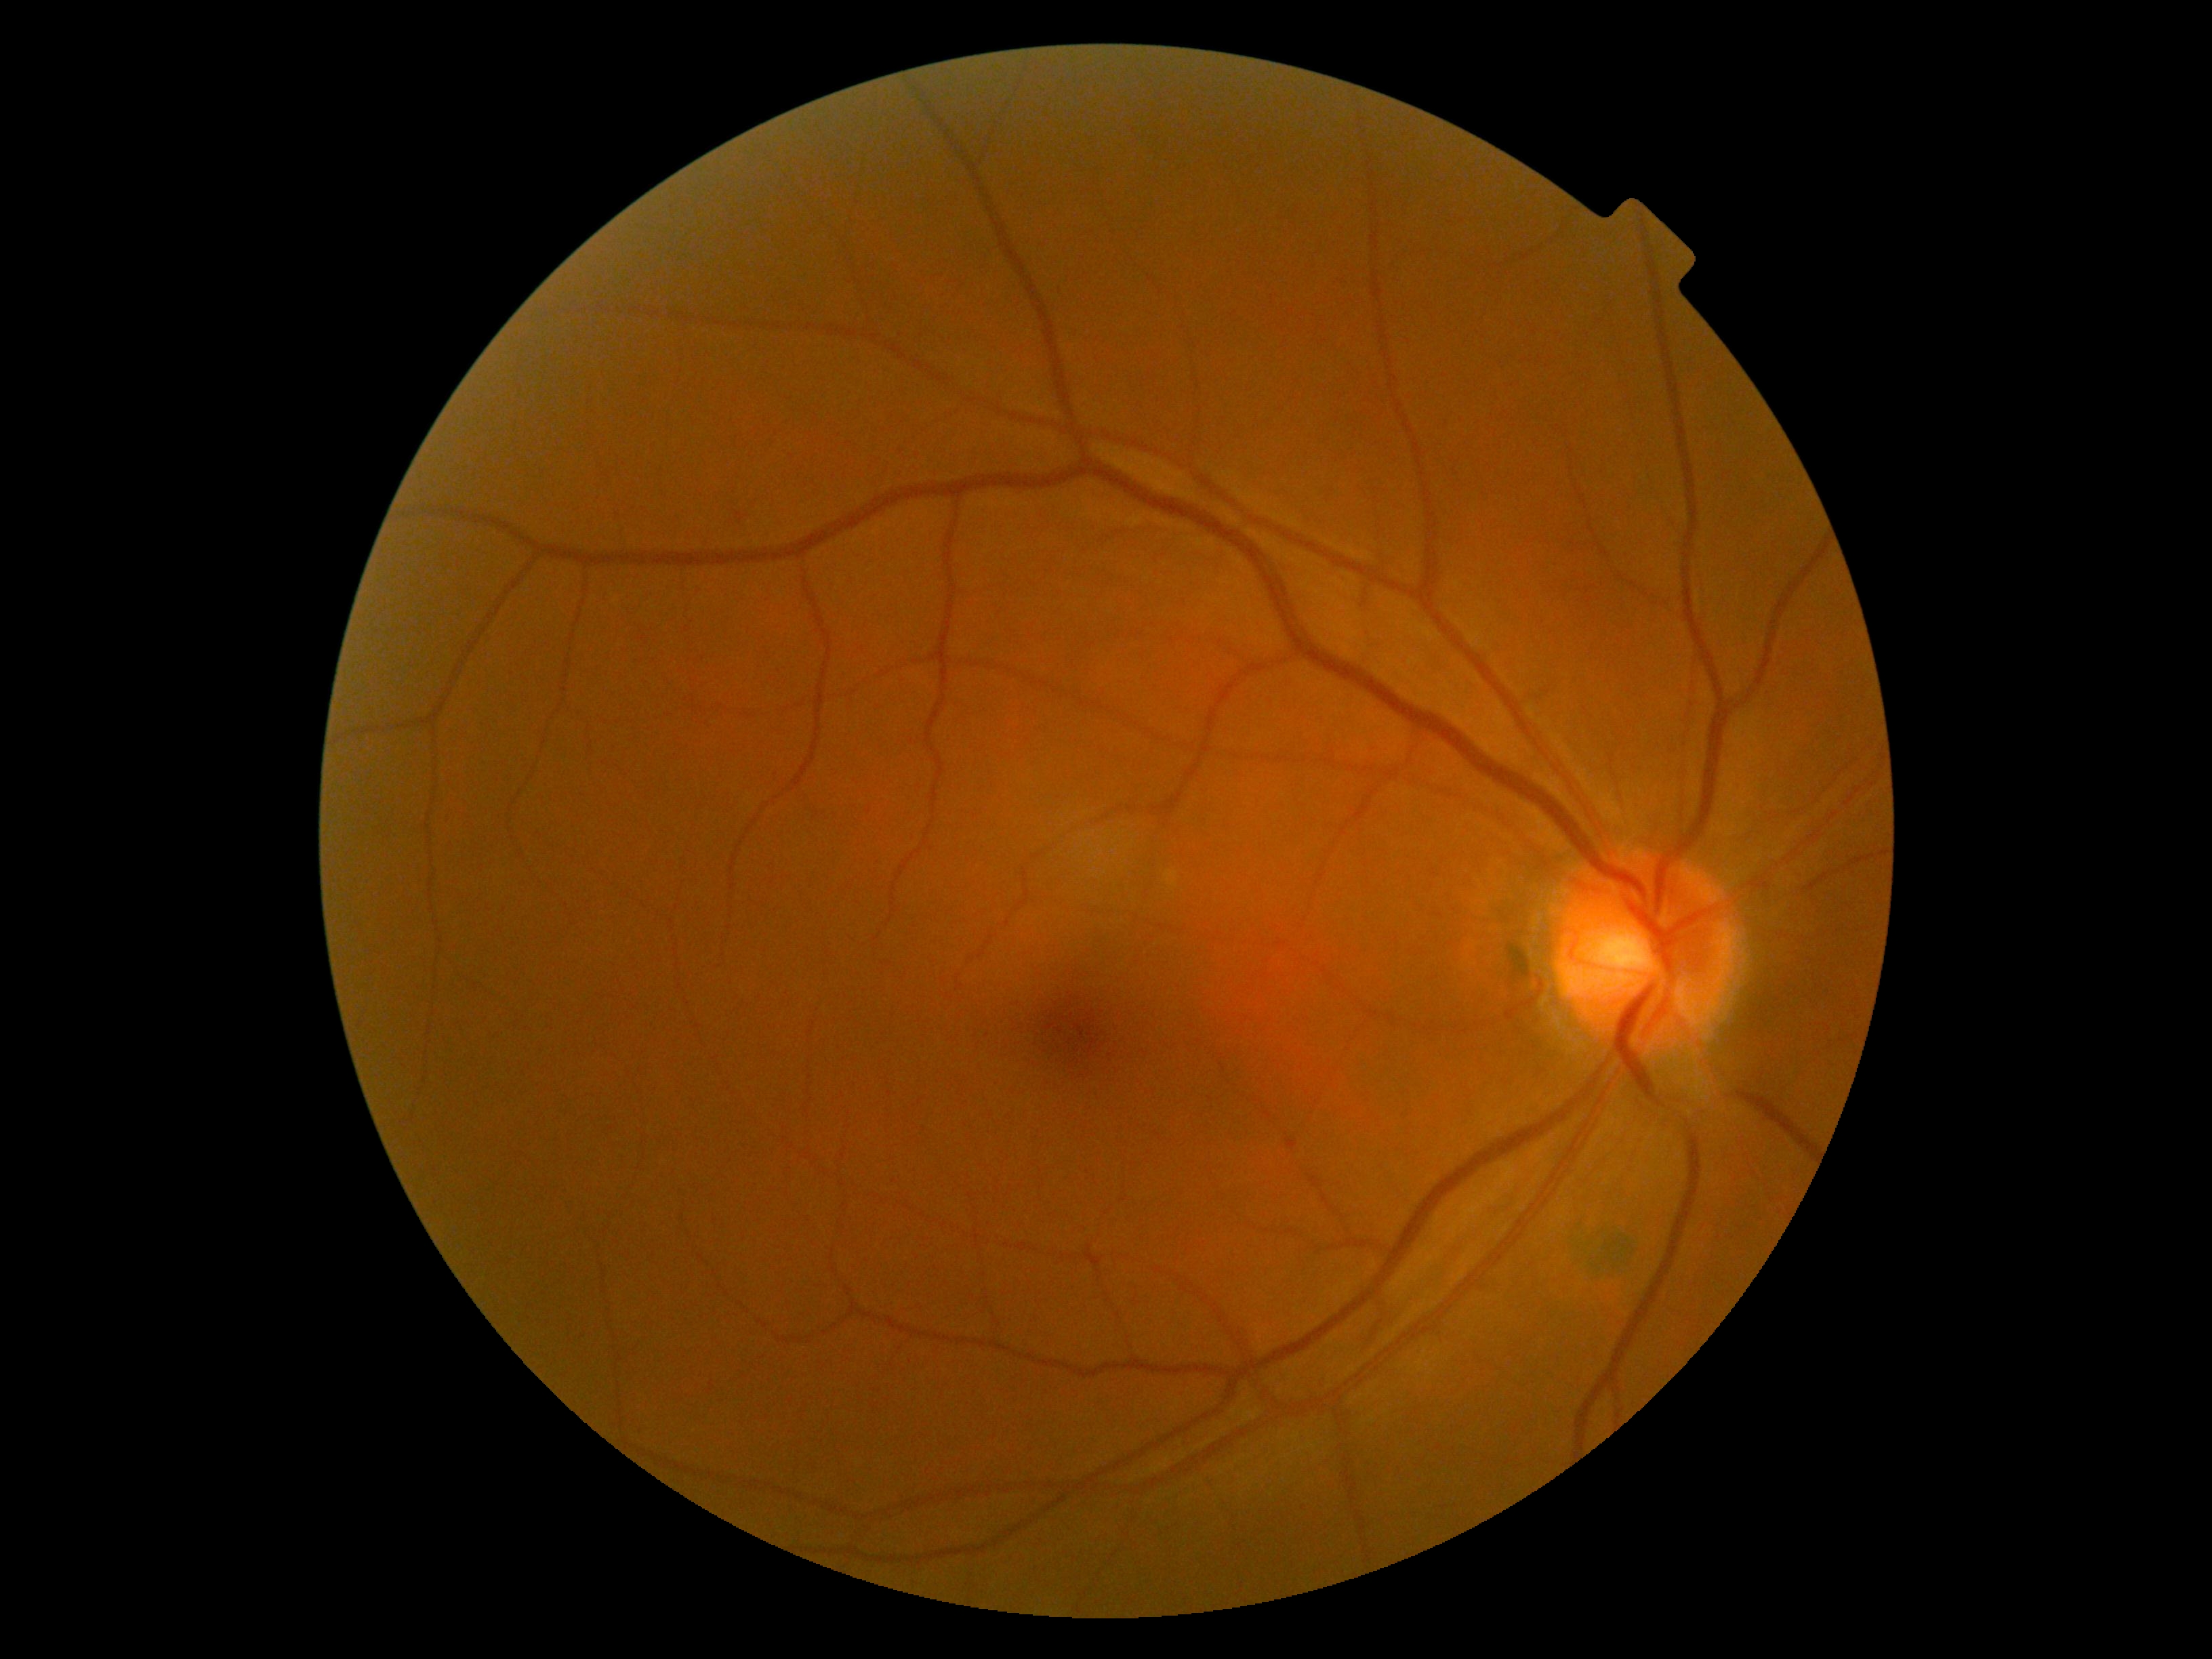 Diabetic retinopathy (DR): grade 0.